Optic disc-centered:
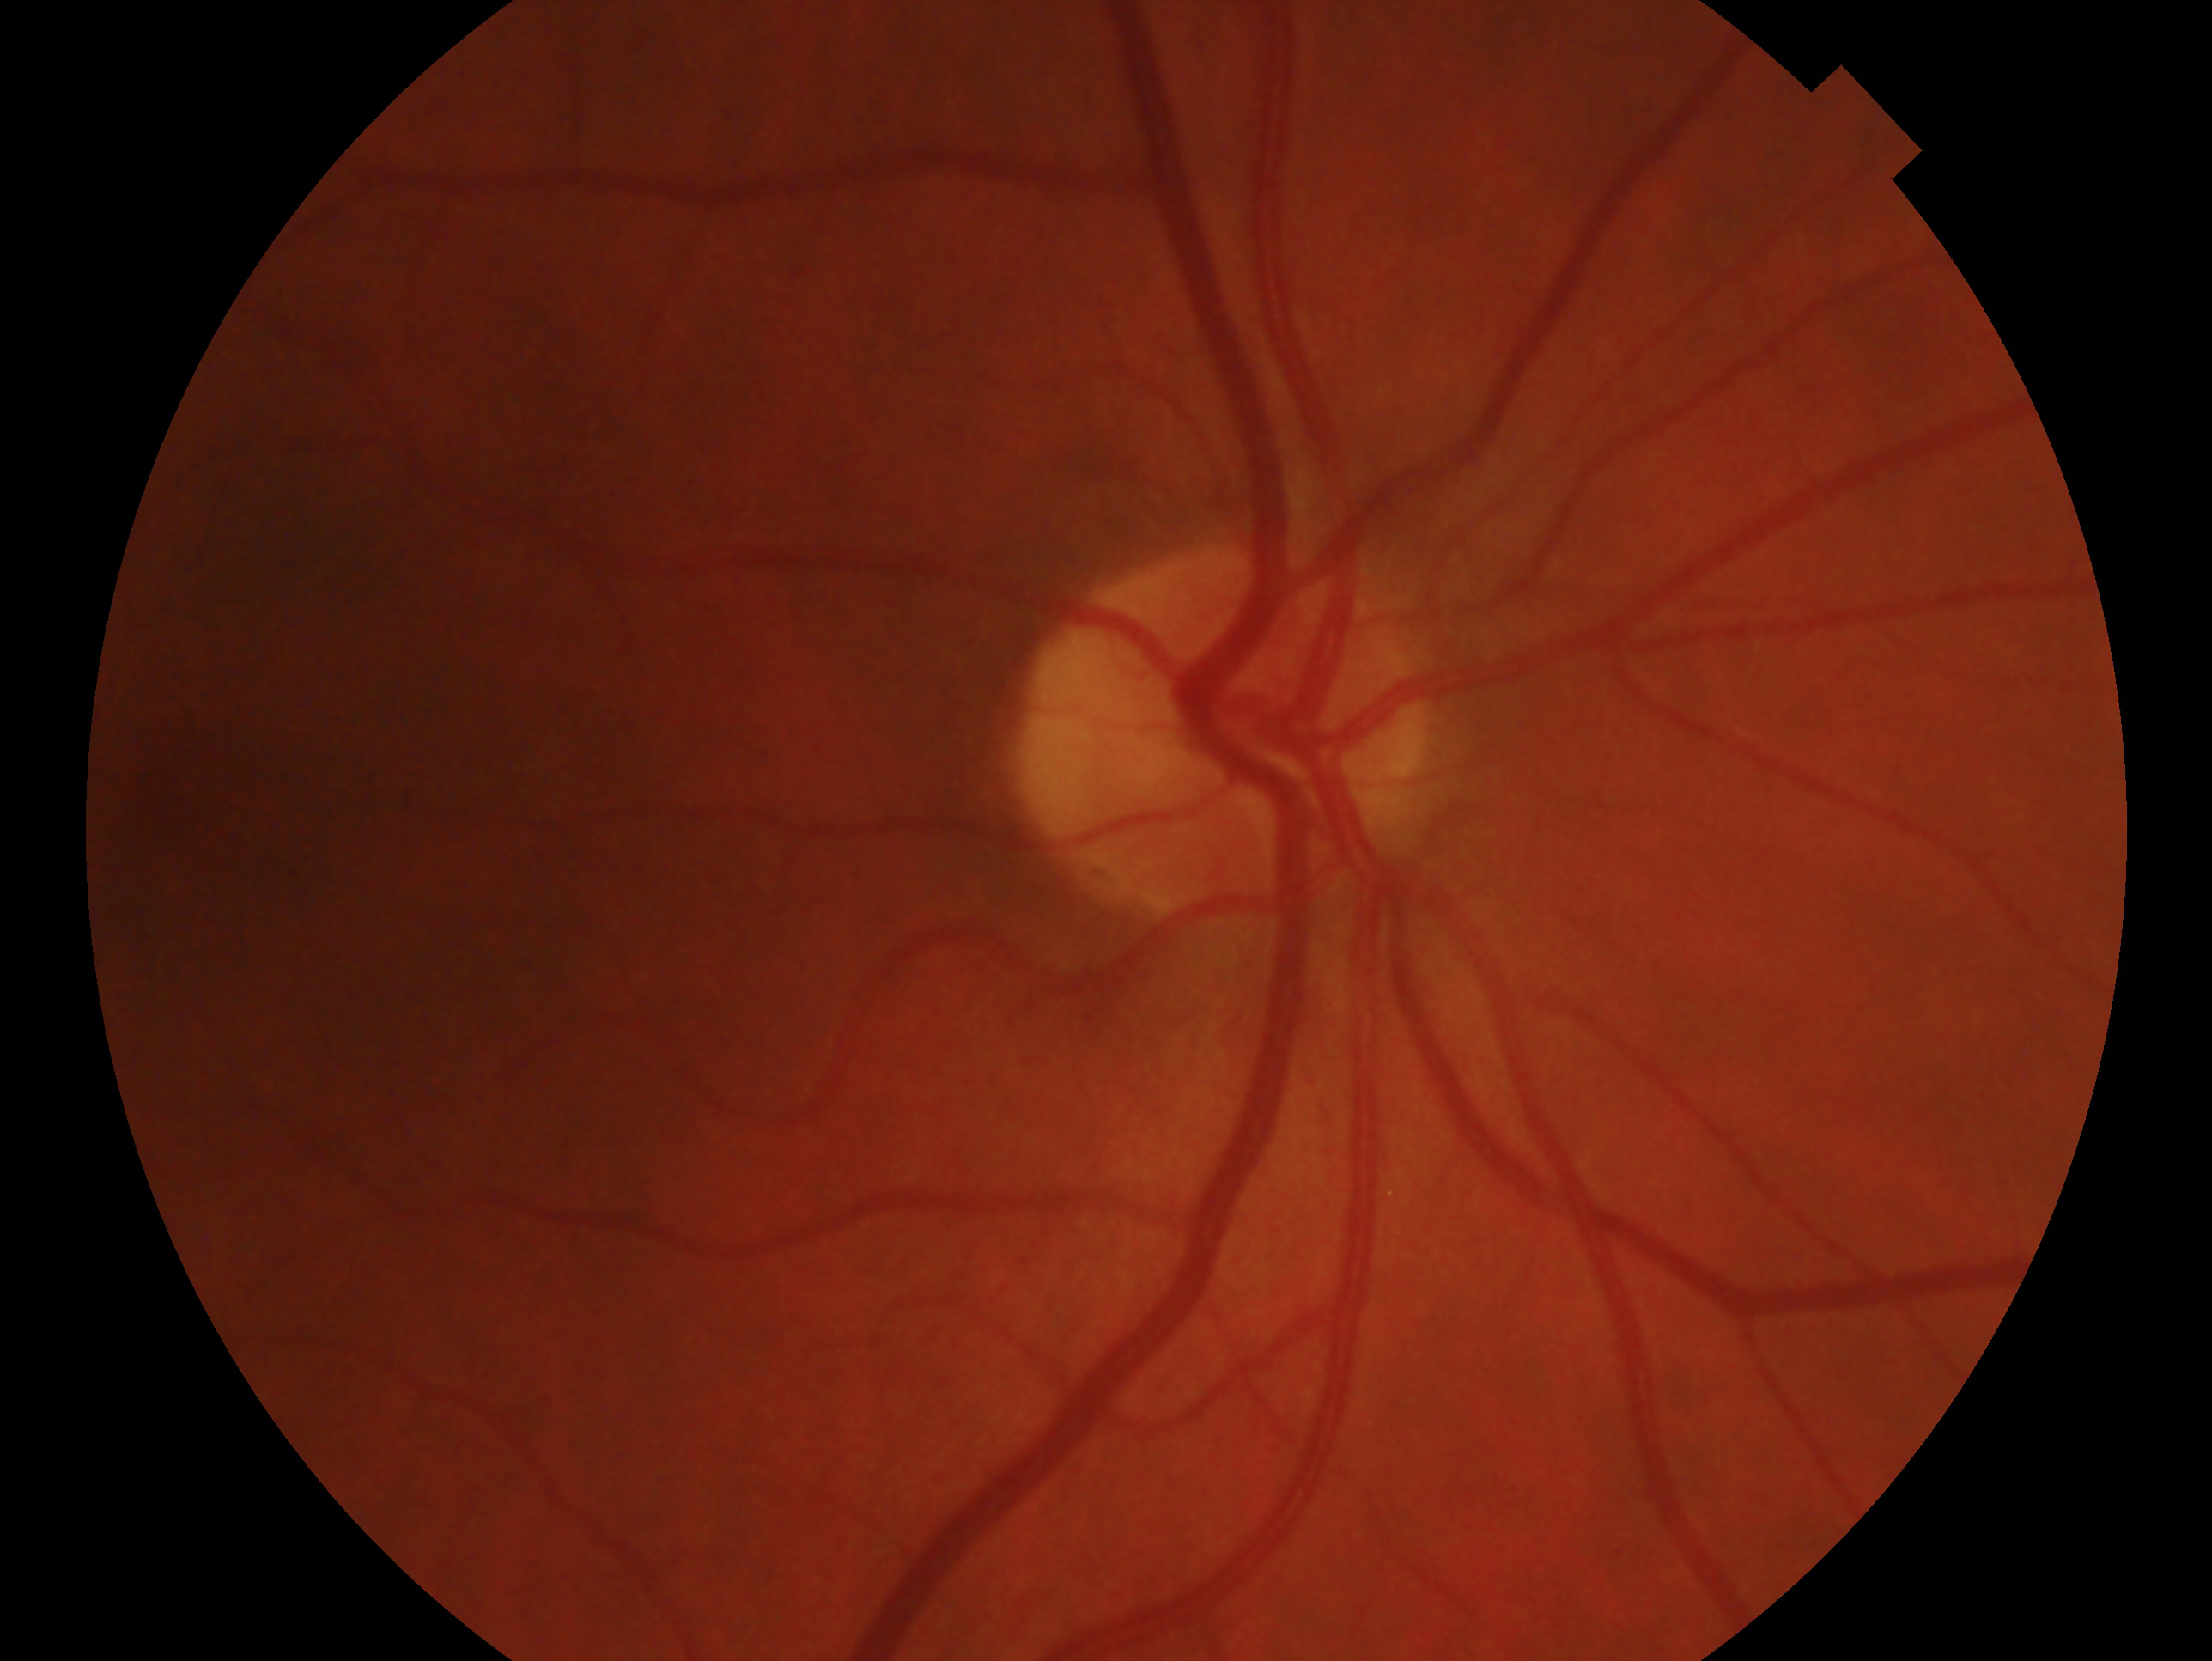
The image shows the OD. Impression — consistent with glaucoma.